Wide-field contact fundus photograph of an infant:
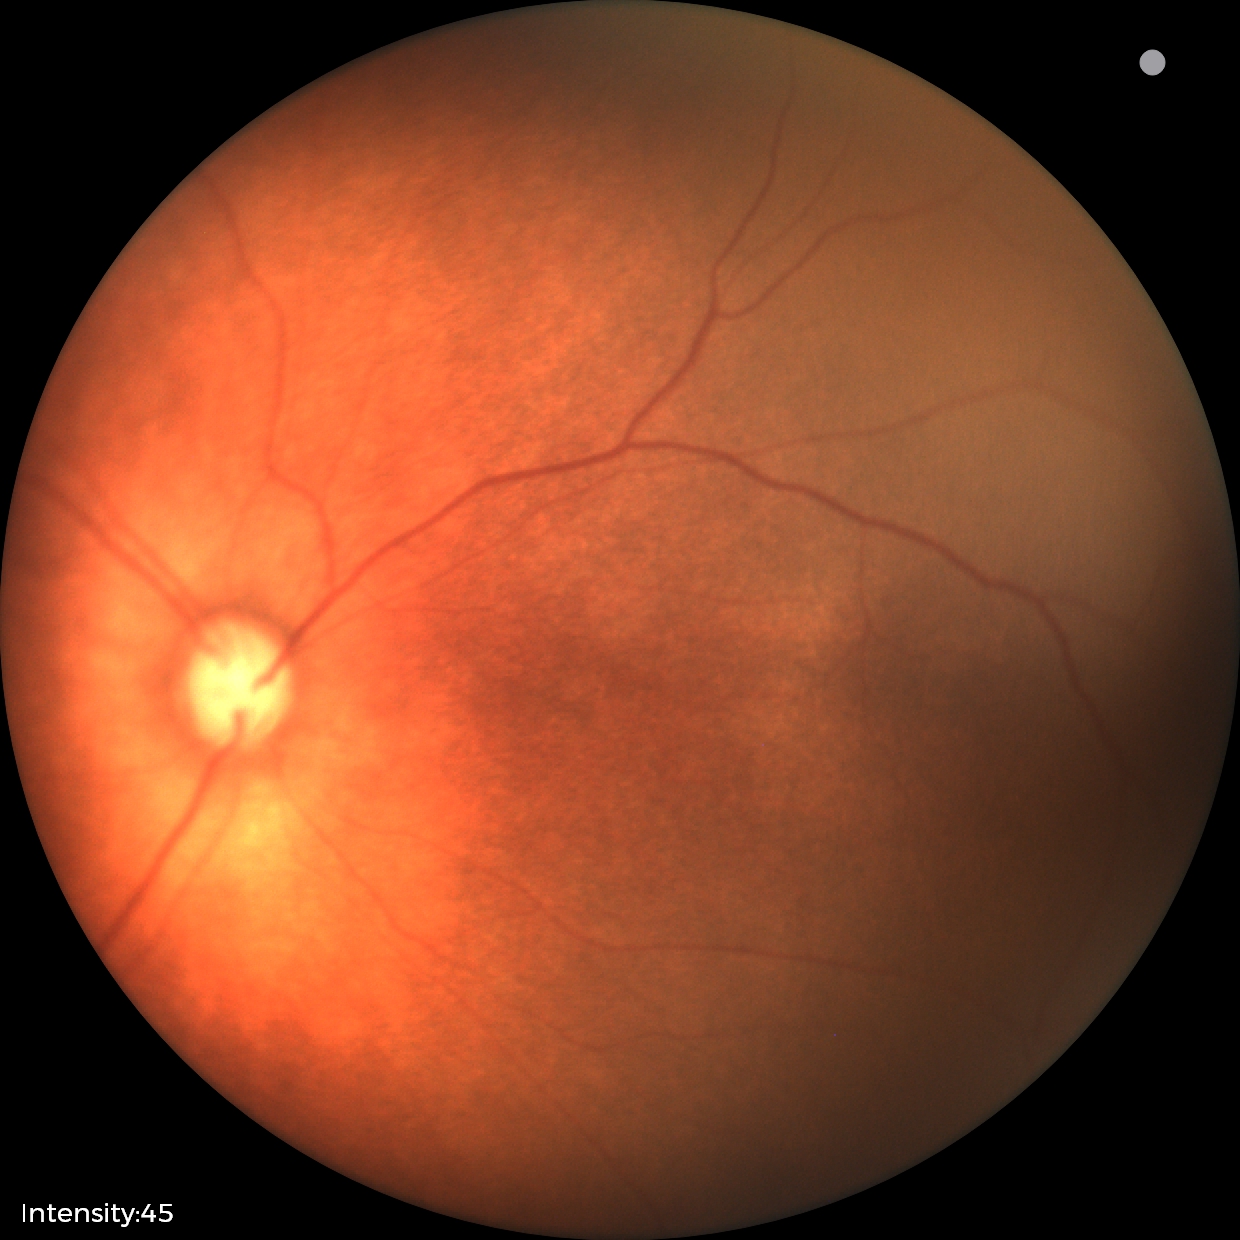
Impression: retinopathy of prematurity stage 2 — ridge with height and width at the demarcation line.